Color fundus image; 2352 x 1568 pixels; 45° field of view:
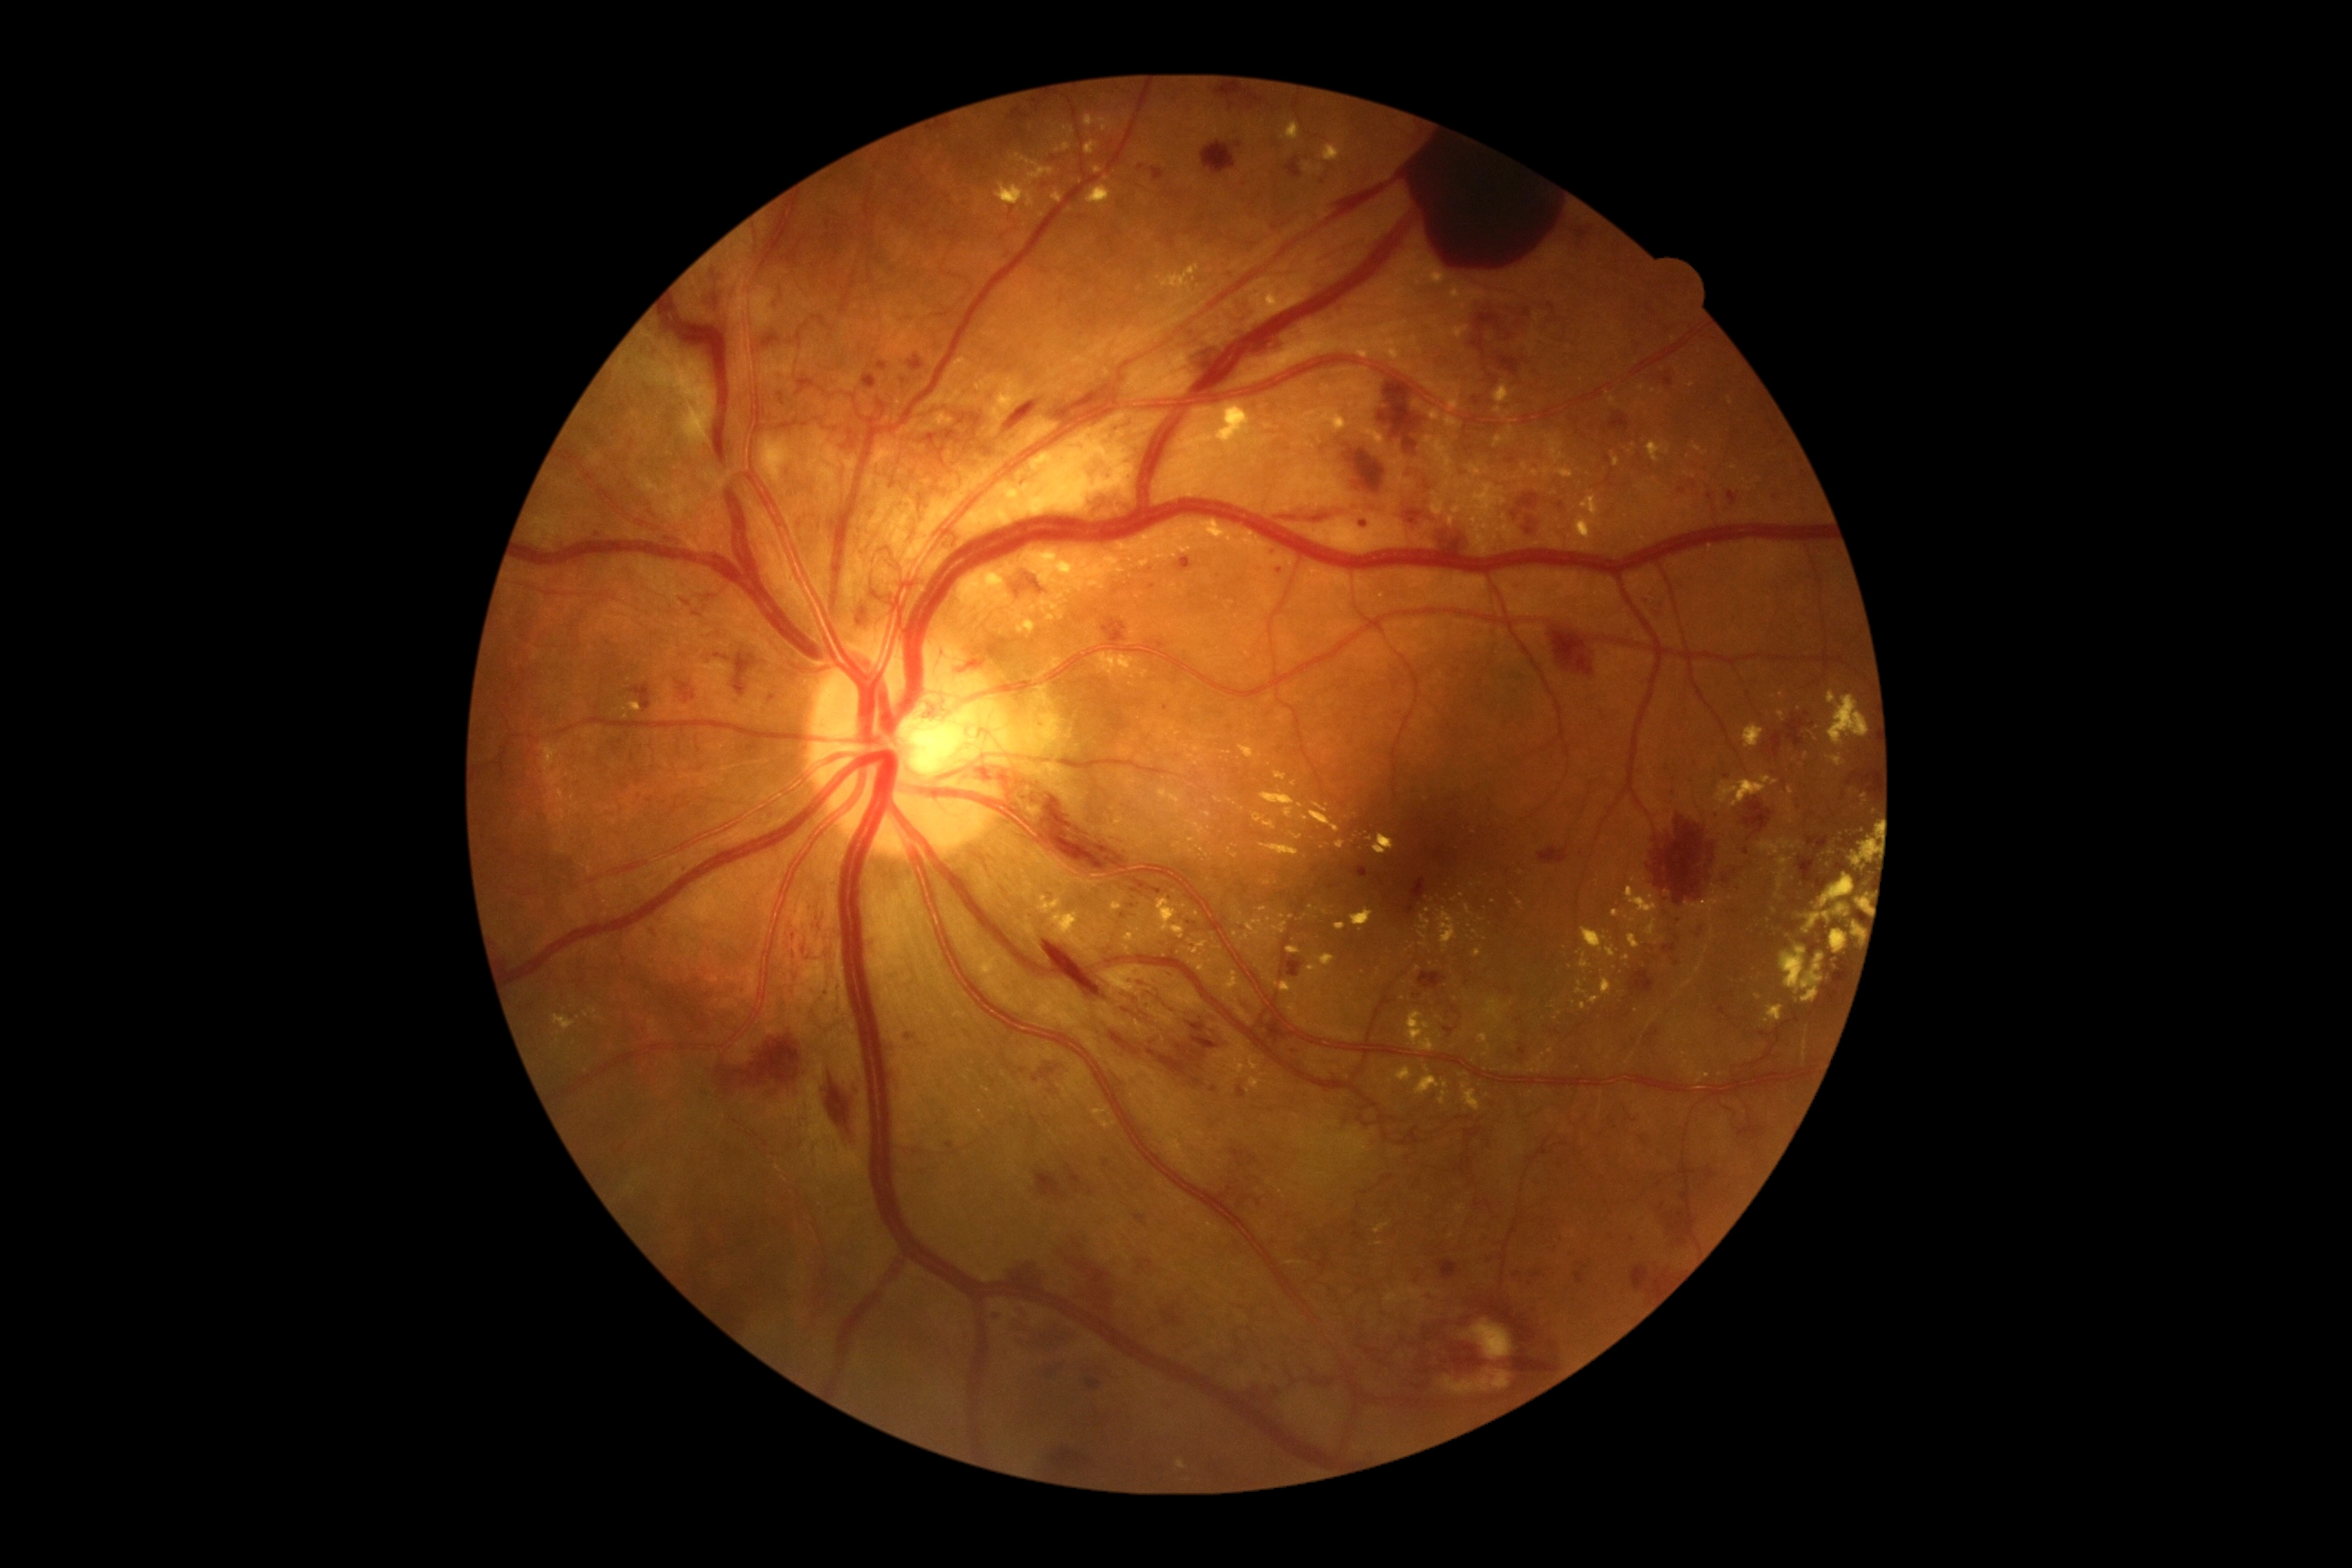 Diabetic retinopathy (DR) is grade 4 — neovascularization and/or vitreous/pre-retinal hemorrhage
A subset of detected lesions:
hard exudates (EXs) (subset) = x1=1629 y1=936 x2=1642 y2=950, x1=1193 y1=745 x2=1202 y2=754, x1=995 y1=155 x2=1055 y2=208, x1=1589 y1=995 x2=1602 y2=1004, x1=1745 y1=725 x2=1765 y2=749, x1=1170 y1=723 x2=1181 y2=736, x1=1112 y1=890 x2=1124 y2=912, x1=1260 y1=790 x2=1297 y2=805, x1=1121 y1=531 x2=1166 y2=553, x1=1861 y1=794 x2=1868 y2=803, x1=1418 y1=375 x2=1462 y2=413, x1=1300 y1=816 x2=1309 y2=821
Small EXs approximately at (1454,901), (1209,828), (1852,792), (1197,914), (1127,949), (1782,695), (1282,916)
hemorrhages (HEs) (subset) = x1=1135 y1=1215 x2=1148 y2=1228, x1=1841 y1=836 x2=1863 y2=848, x1=1854 y1=912 x2=1861 y2=921, x1=707 y1=264 x2=732 y2=338, x1=1727 y1=491 x2=1738 y2=504, x1=1066 y1=1166 x2=1083 y2=1191, x1=1787 y1=923 x2=1798 y2=930, x1=986 y1=1309 x2=1004 y2=1322, x1=1469 y1=315 x2=1500 y2=360, x1=1406 y1=879 x2=1427 y2=916, x1=718 y1=1037 x2=801 y2=1102, x1=1028 y1=1059 x2=1070 y2=1084, x1=1119 y1=894 x2=1139 y2=919, x1=1444 y1=1028 x2=1455 y2=1037
Small HEs approximately at (1663,1207), (1083,217), (1228,589), (633,443)